1960x1897; 45° field of view — 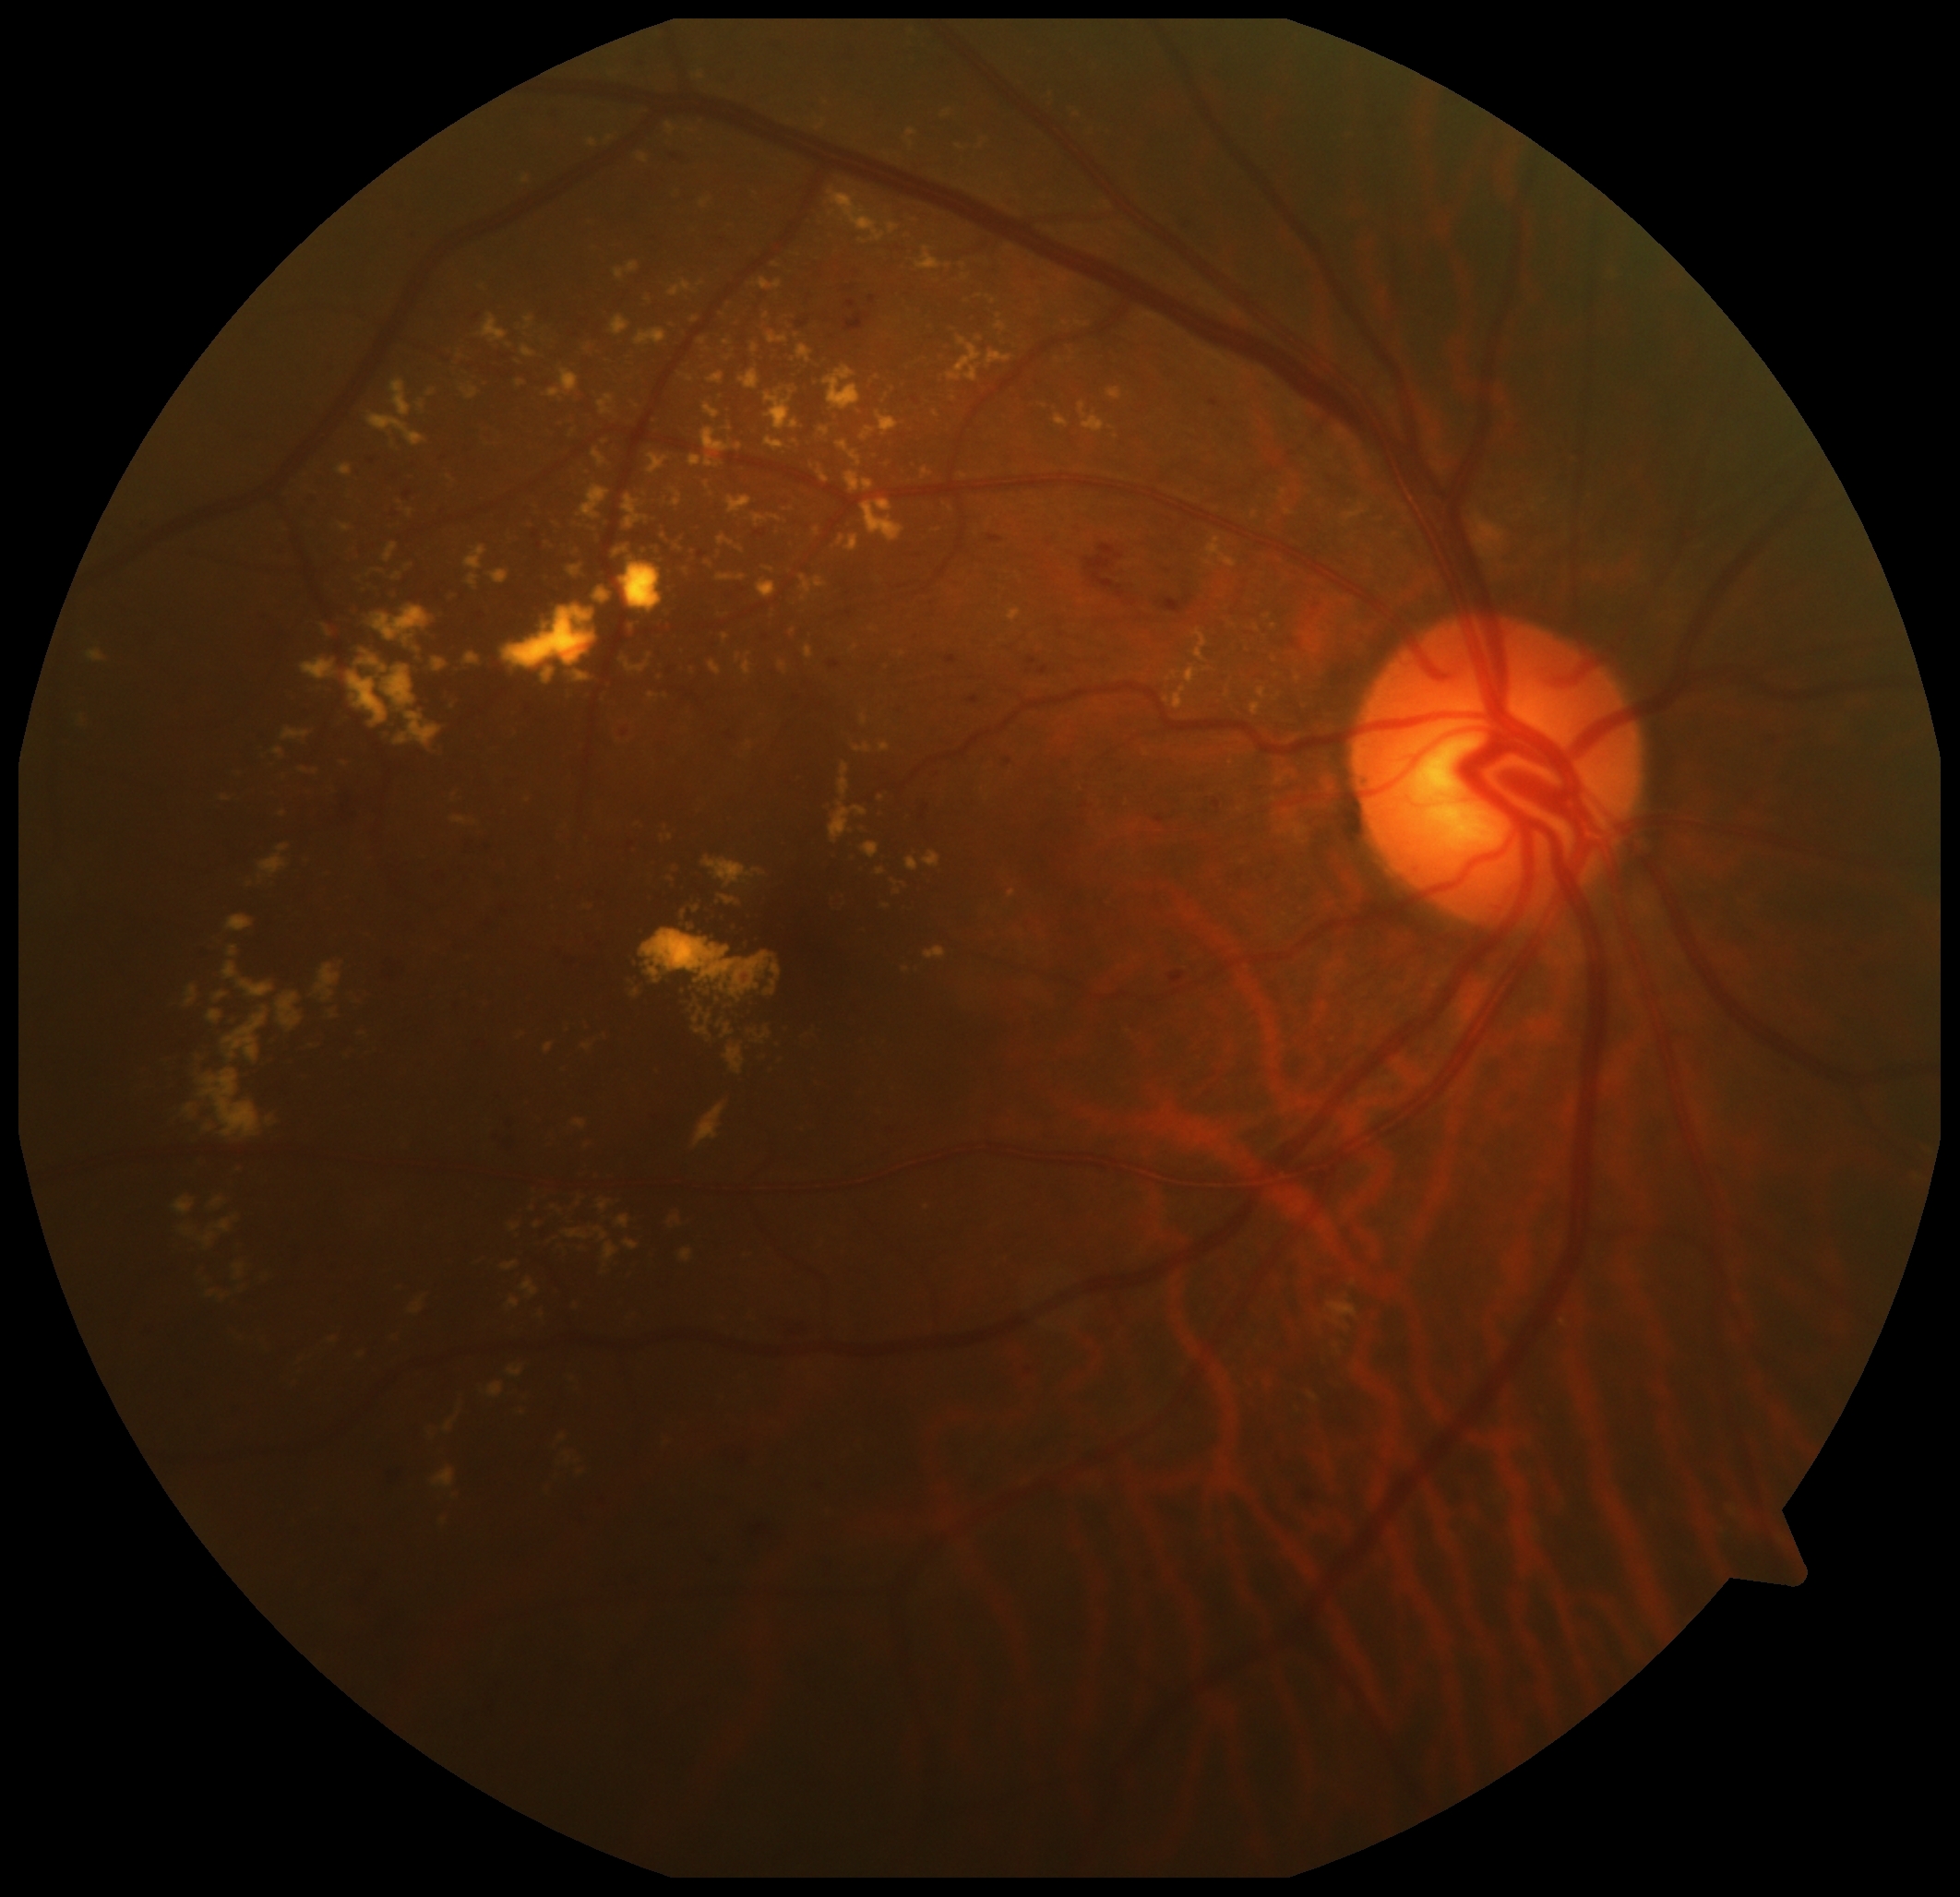
DR class: non-proliferative diabetic retinopathy.
Diabetic retinopathy severity is 2.